848 by 848 pixels. NIDEK AFC-230 fundus camera. Color fundus photograph:
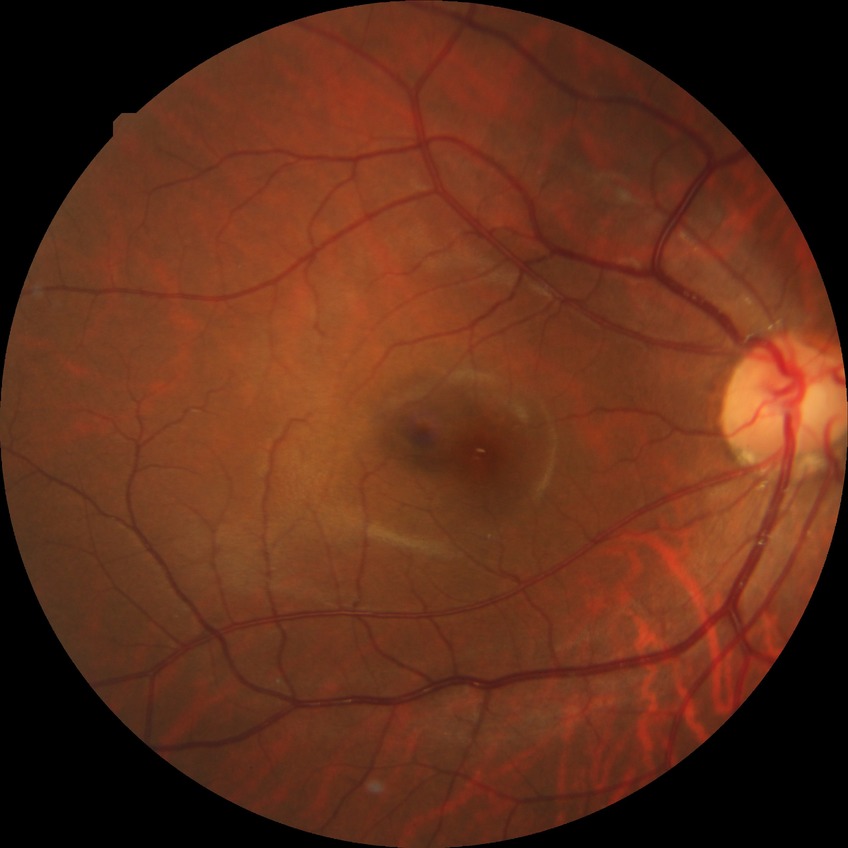
Diabetic retinopathy (DR): no diabetic retinopathy (NDR).